Nonmydriatic · graded on the modified Davis scale · NIDEK AFC-230: 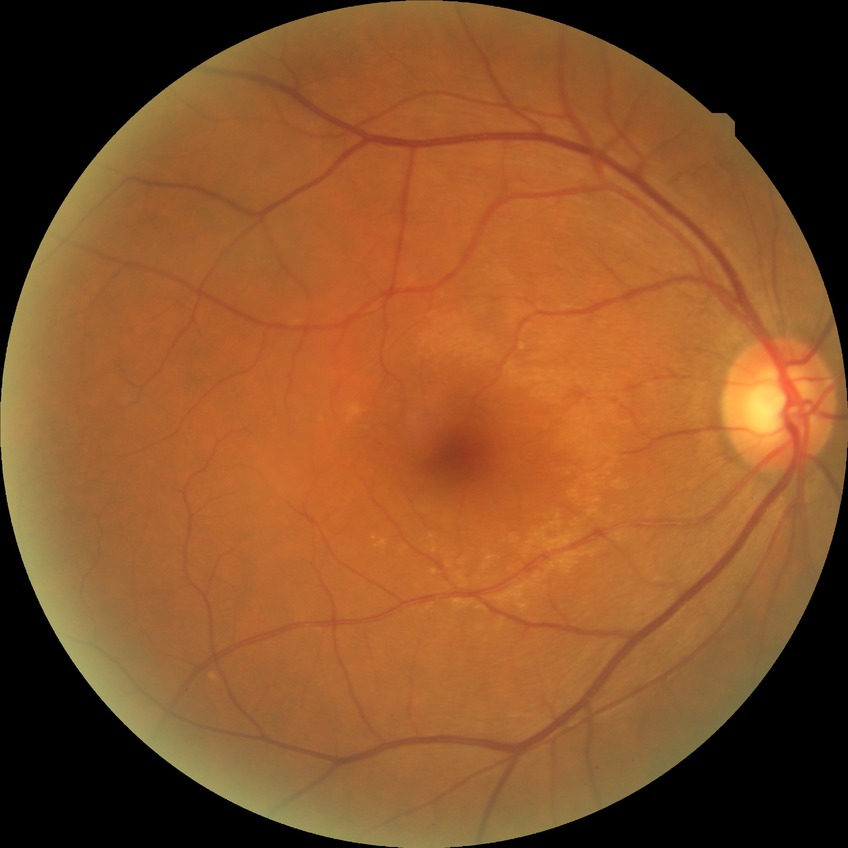

retinopathy grade = no diabetic retinopathy.